Image size 848x848. Graded on the modified Davis scale. Acquired with a NIDEK AFC-230 — 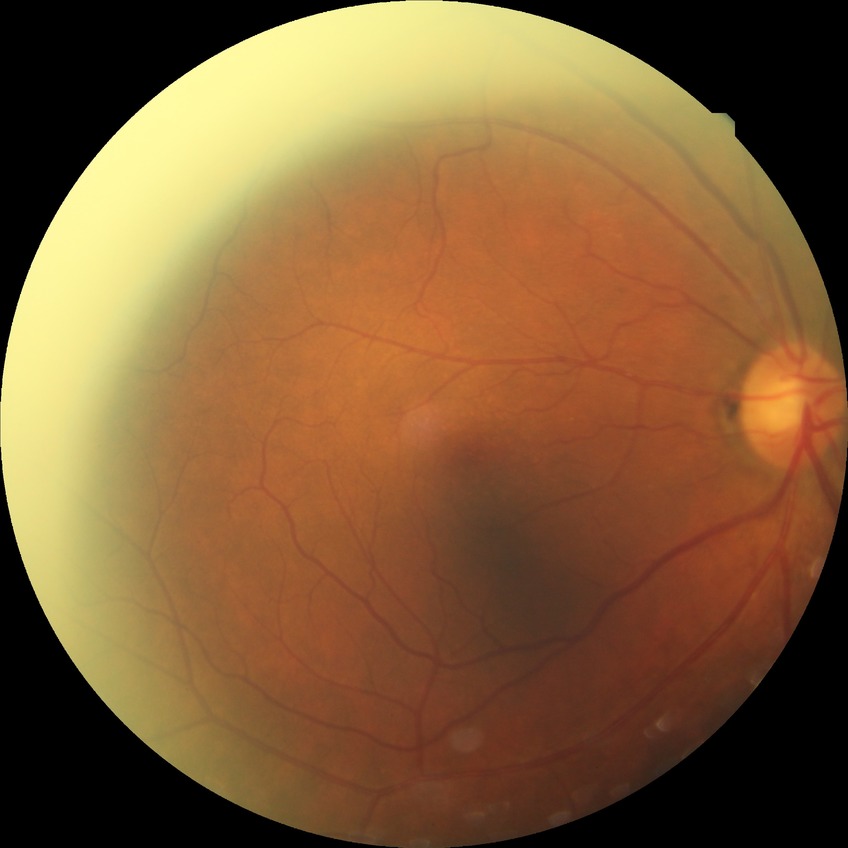

Diabetic retinopathy stage is no diabetic retinopathy.